Camera: Phoenix ICON (100° FOV); 1240x1240px; wide-field contact fundus photograph of an infant — 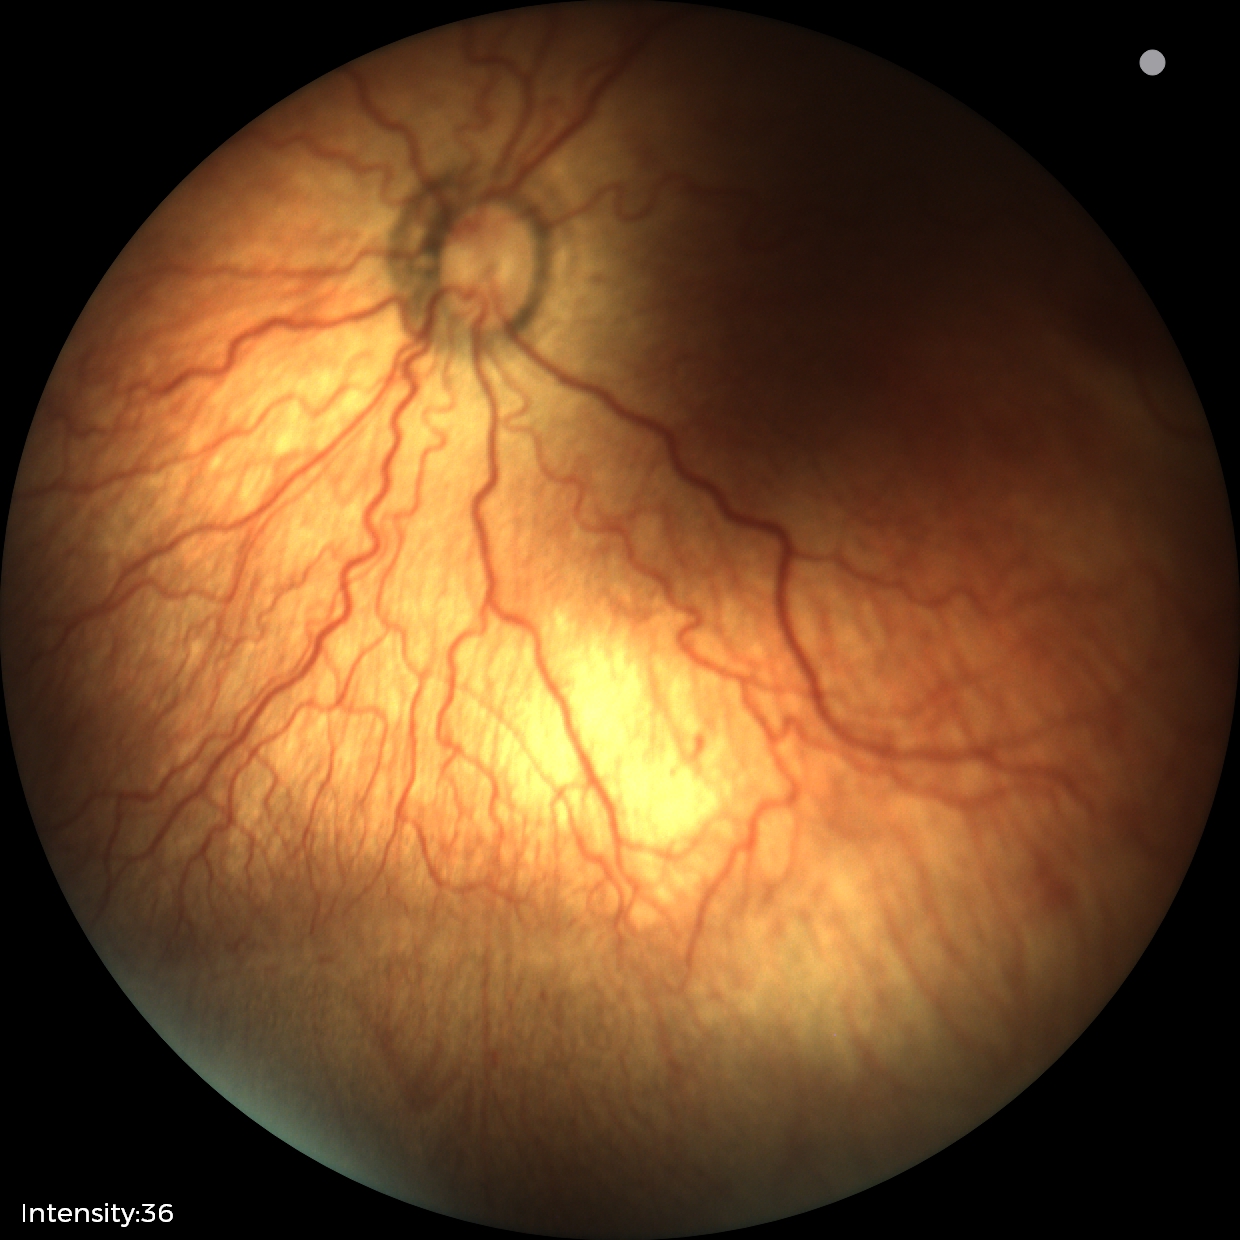
Series diagnosed as ROP stage 2.